Retinal fundus photograph:
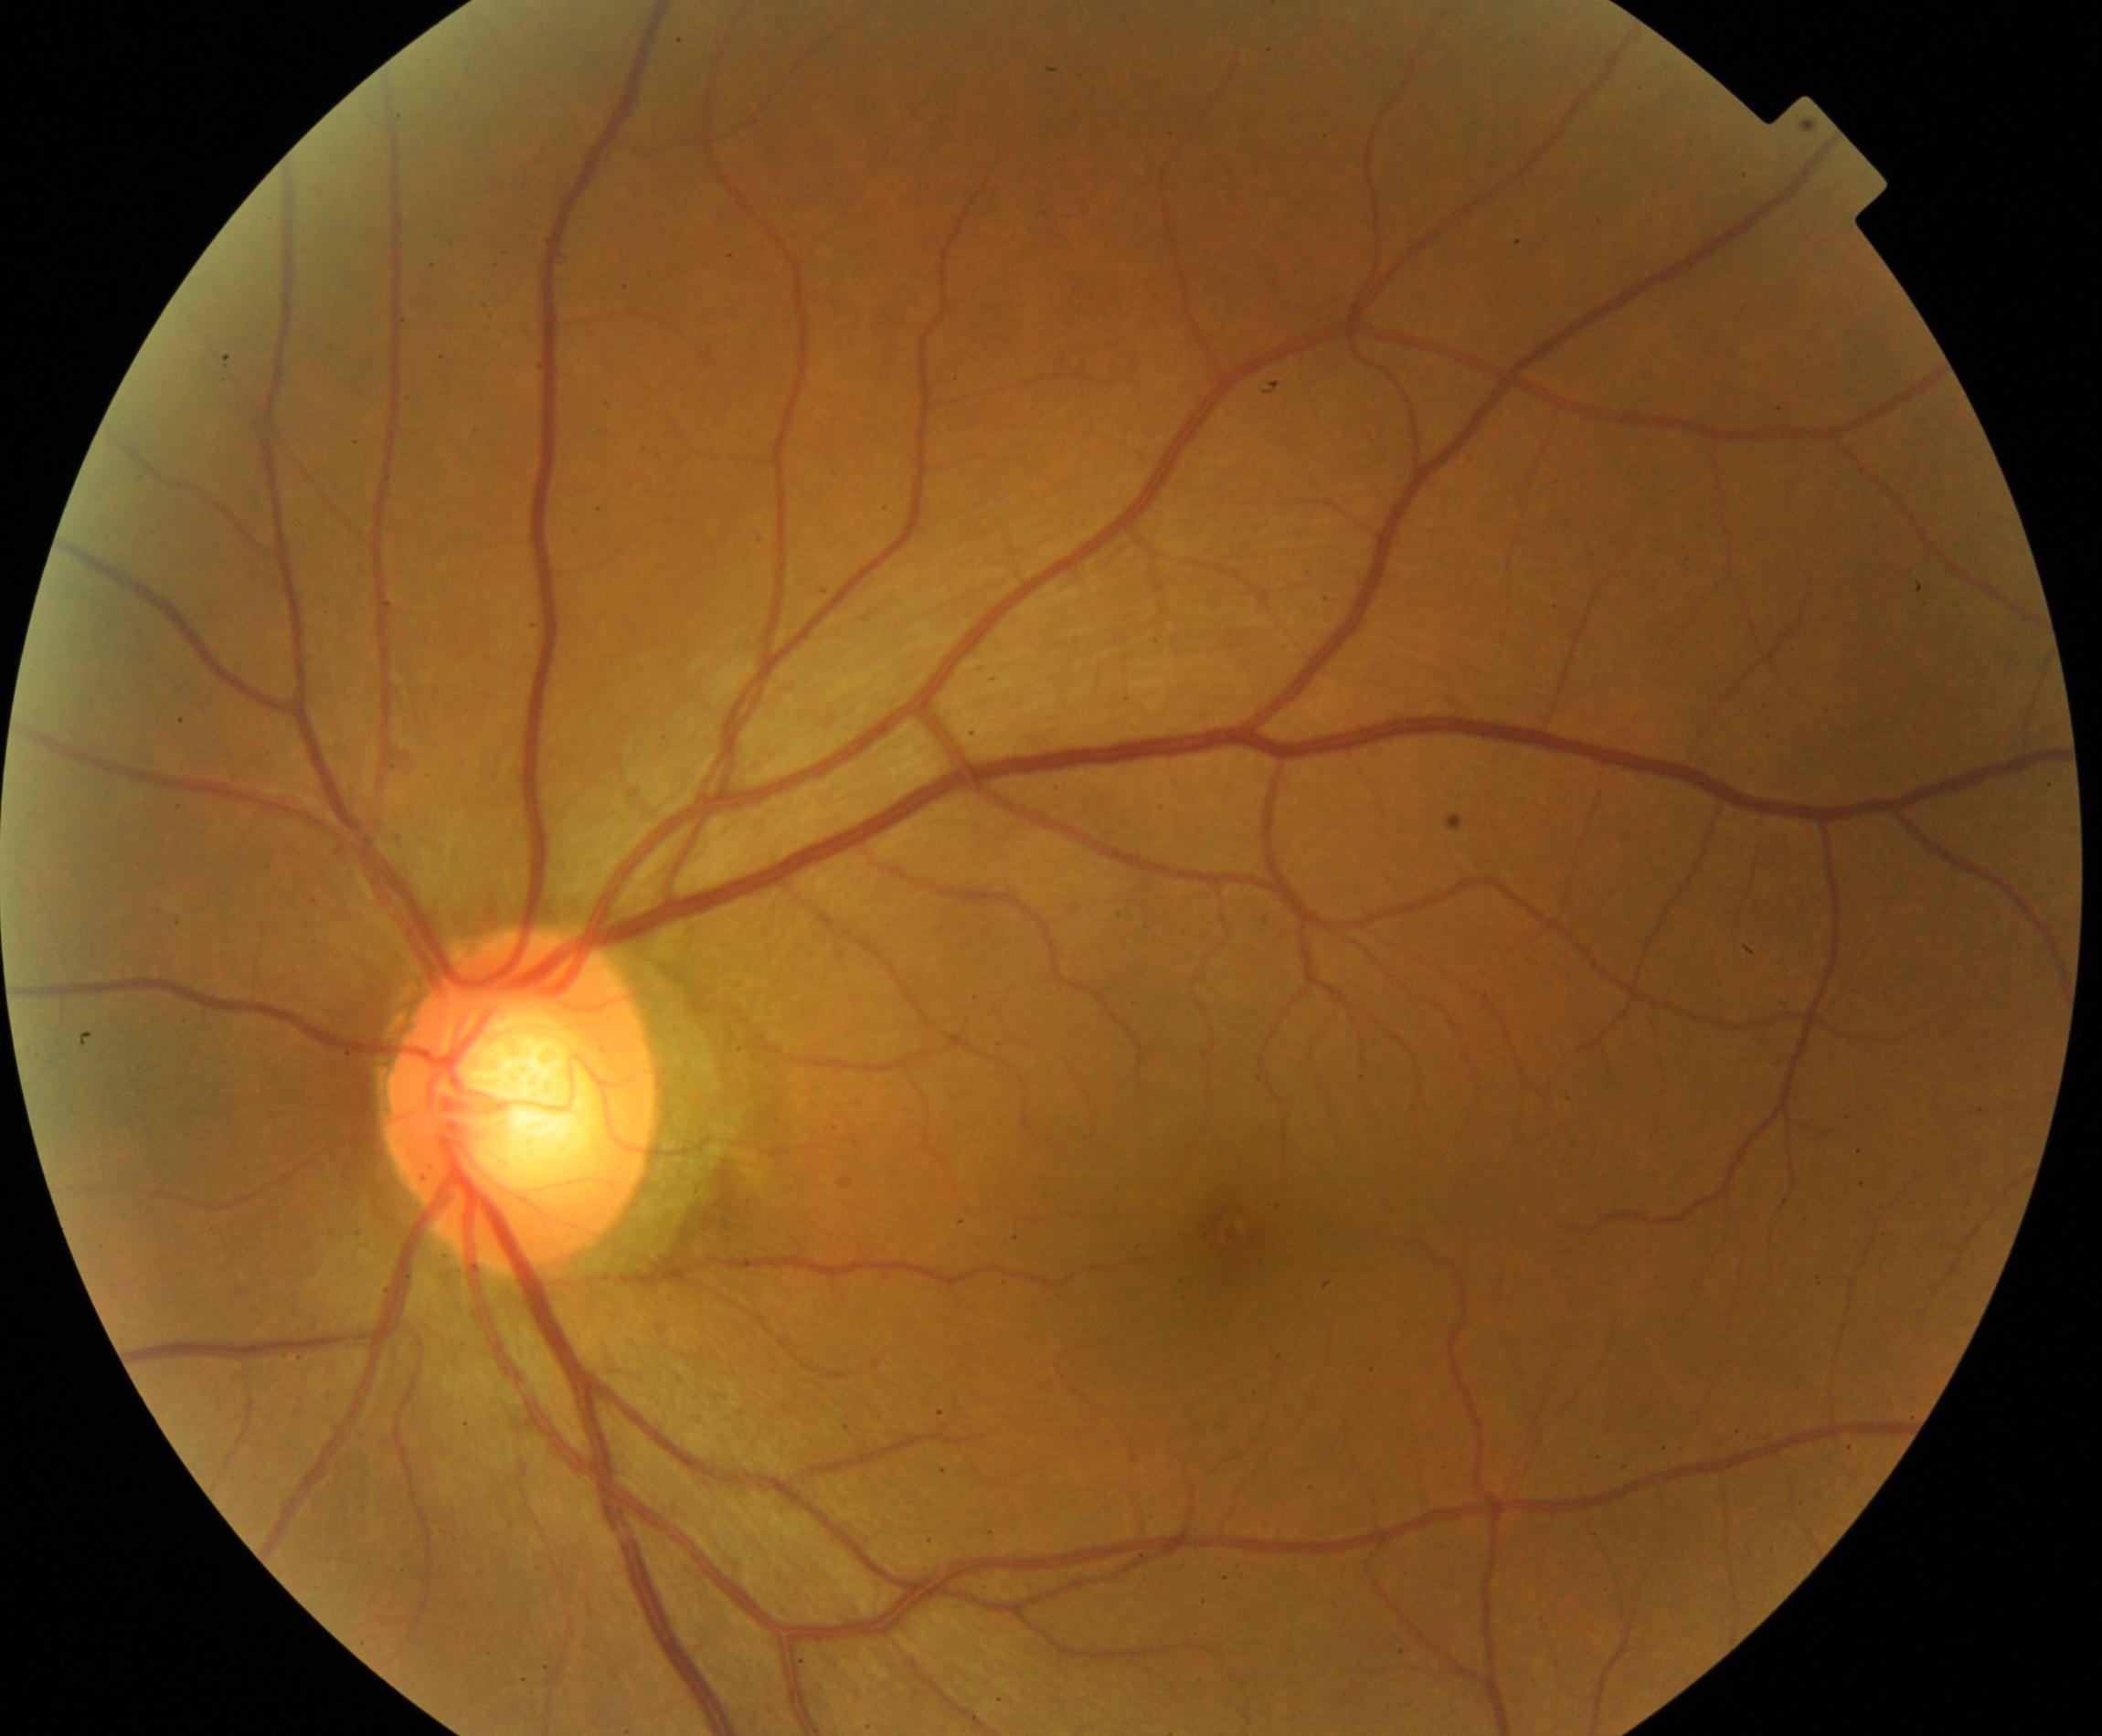 Demonstrates large optic cup.